Wide-field contact fundus photograph of an infant — 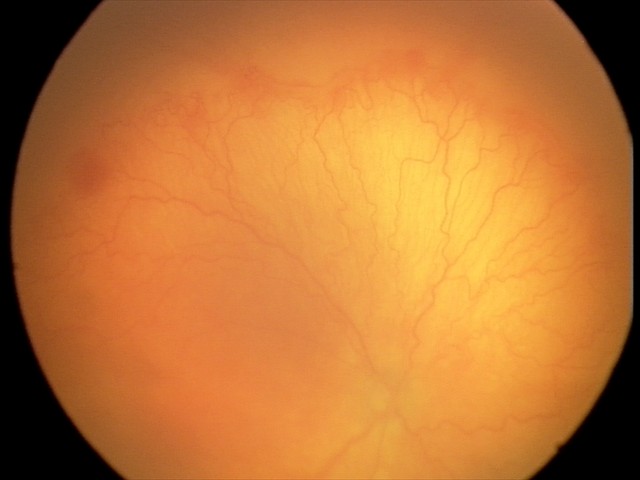
With plus disease. From an examination with diagnosis of aggressive retinopathy of prematurity.